2352 by 1568 pixels. CFP. 45° field of view: 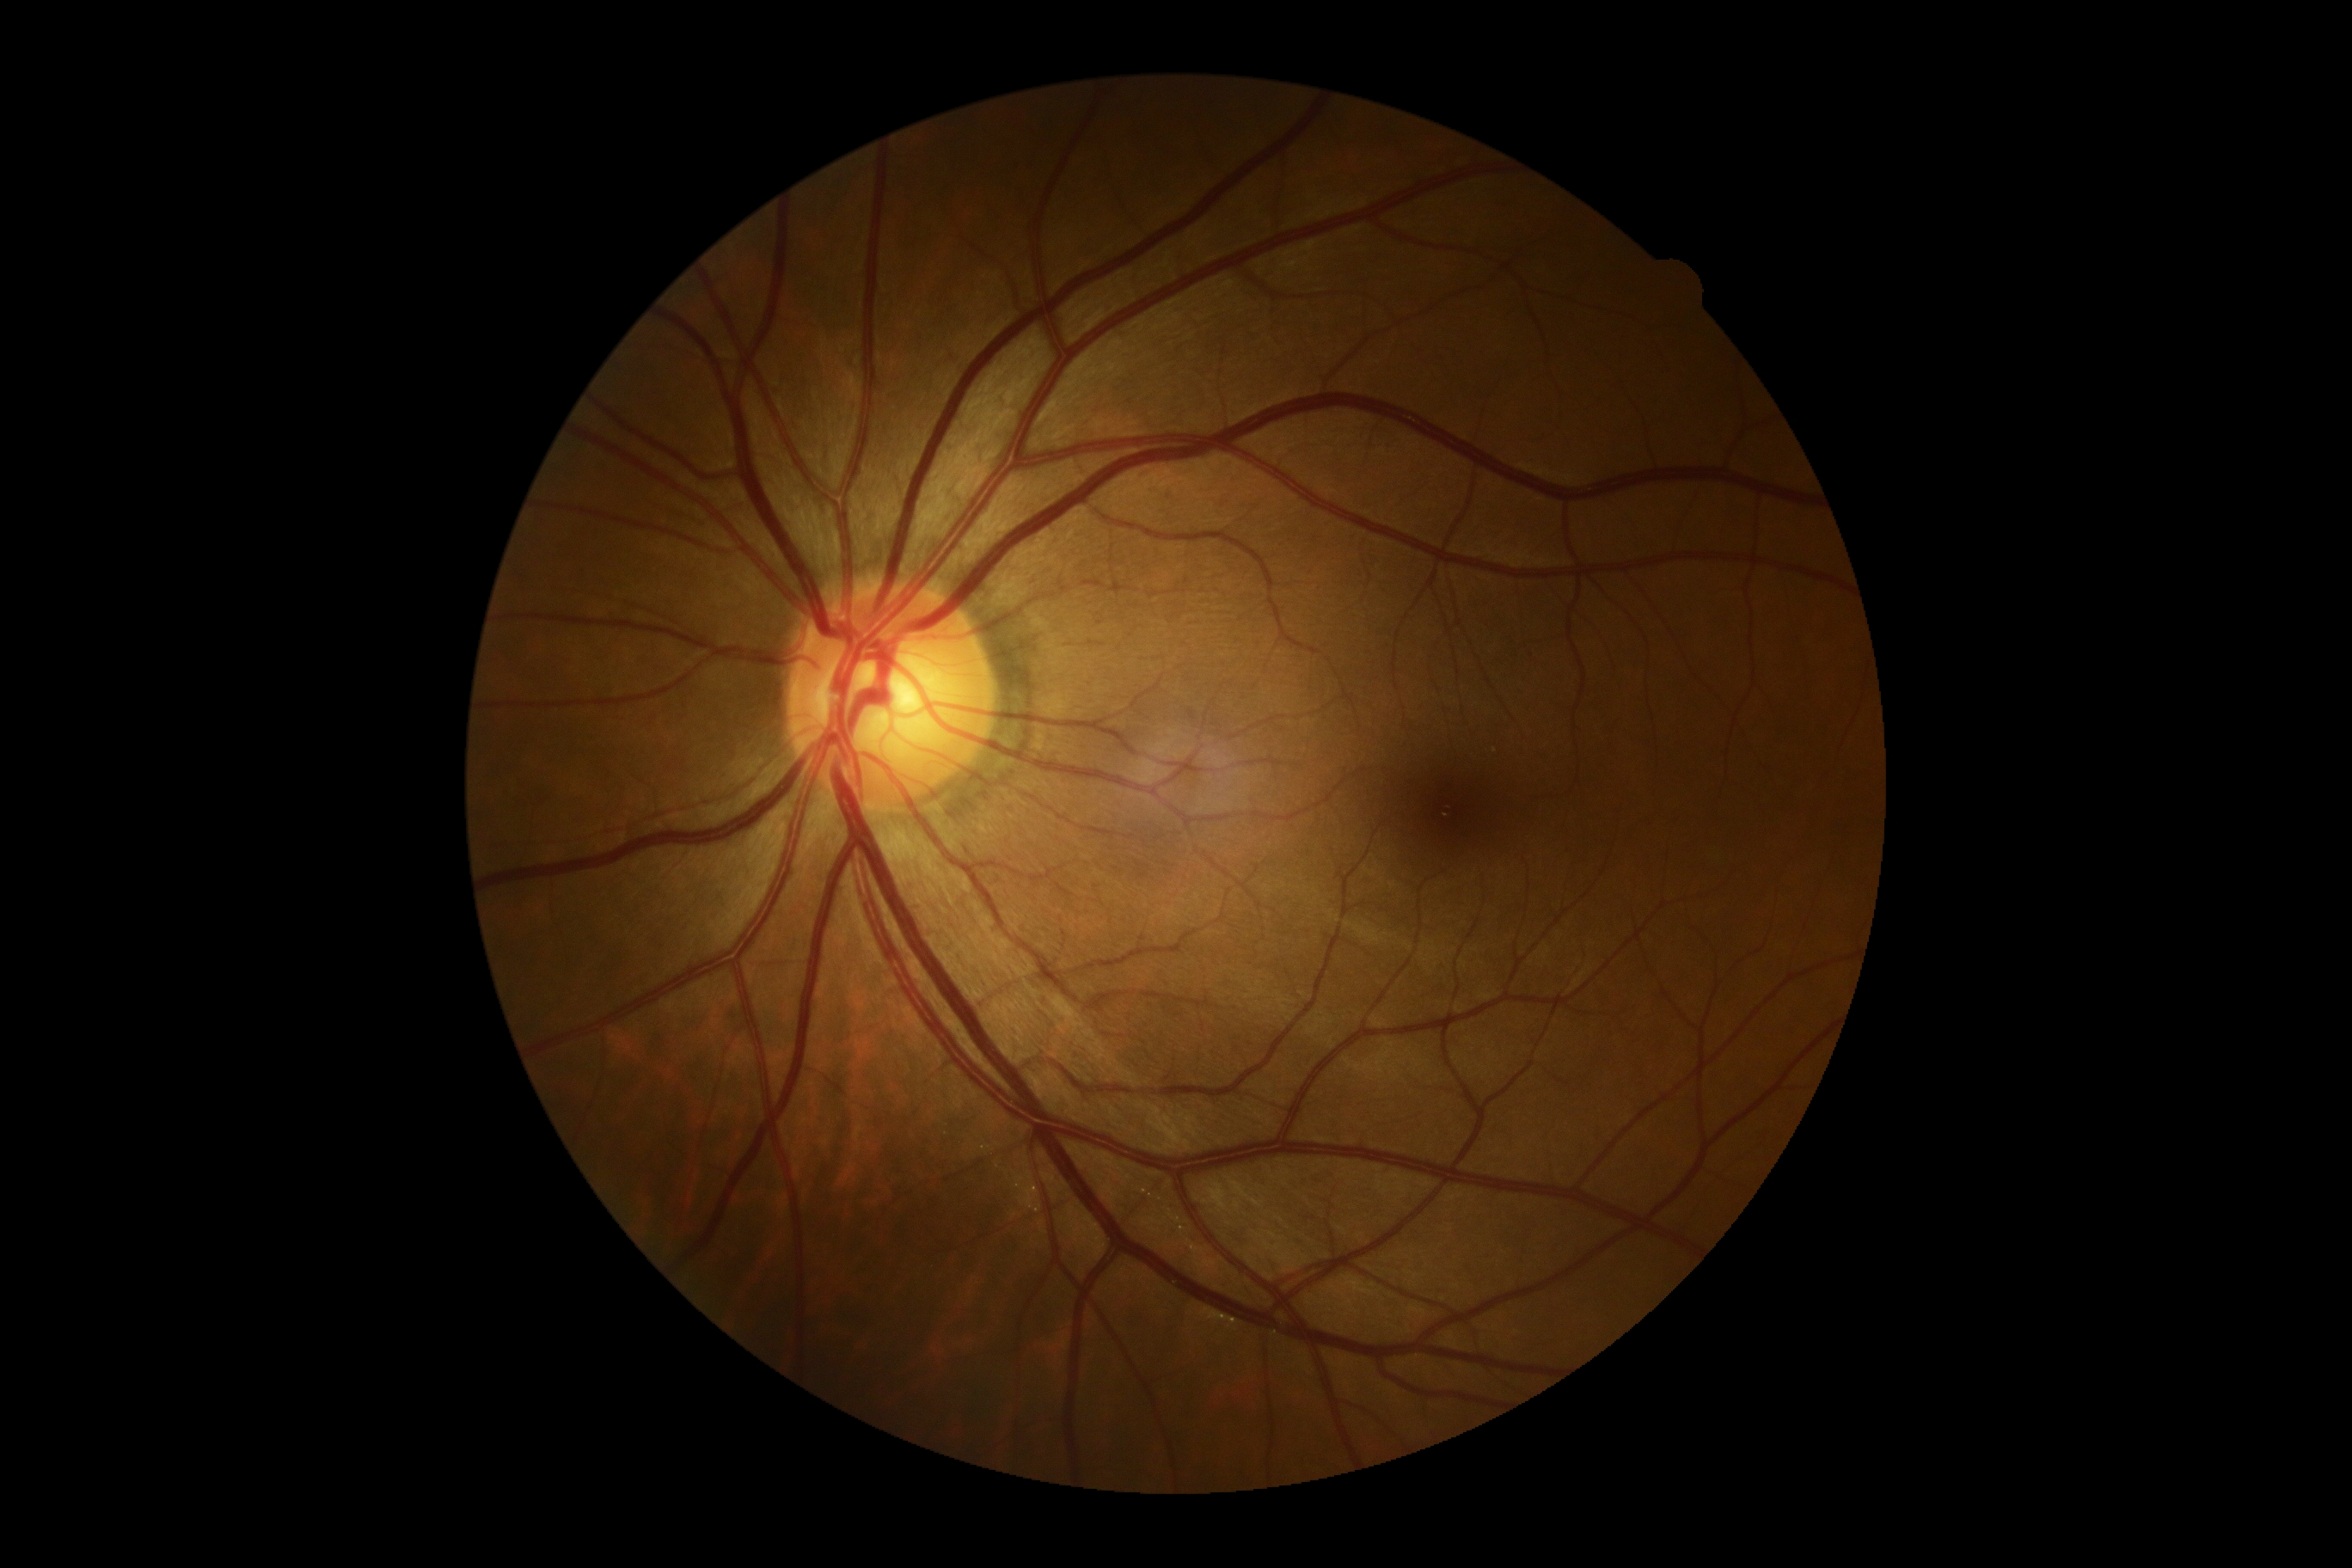 Diabetic retinopathy (DR) is grade 0 (no apparent retinopathy).